Acquired with a Nidek AFC-330:
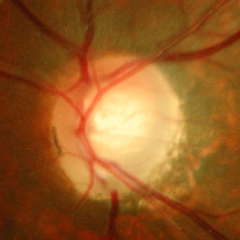

Early-stage glaucoma.